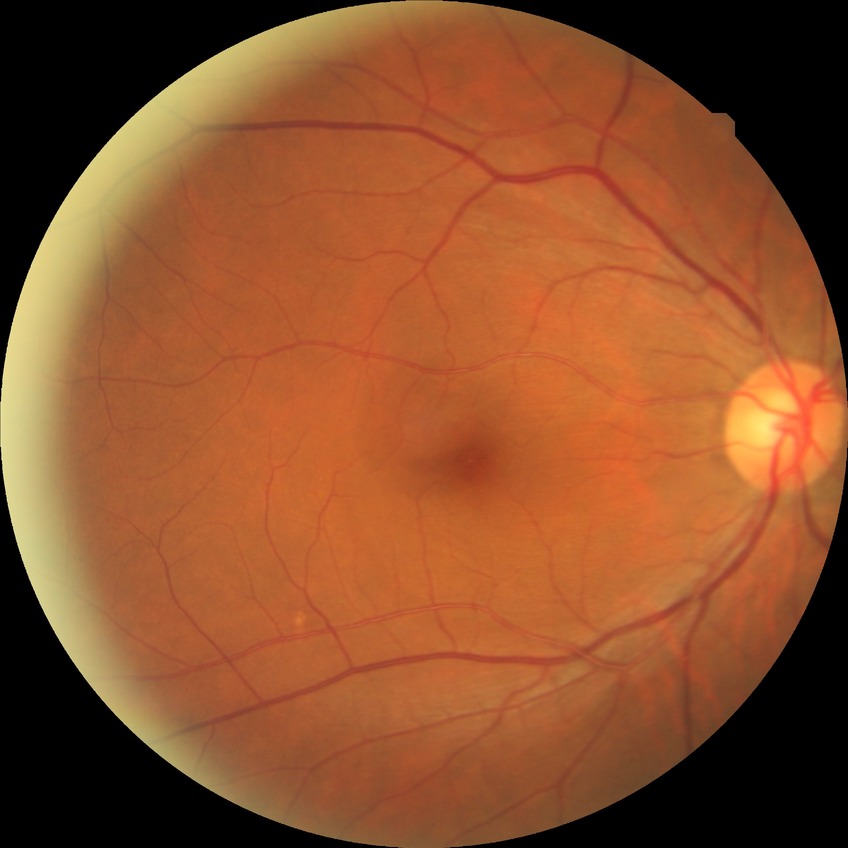

Diabetic retinopathy (DR) is no diabetic retinopathy (NDR).